Camera: NIDEK AFC-230 — 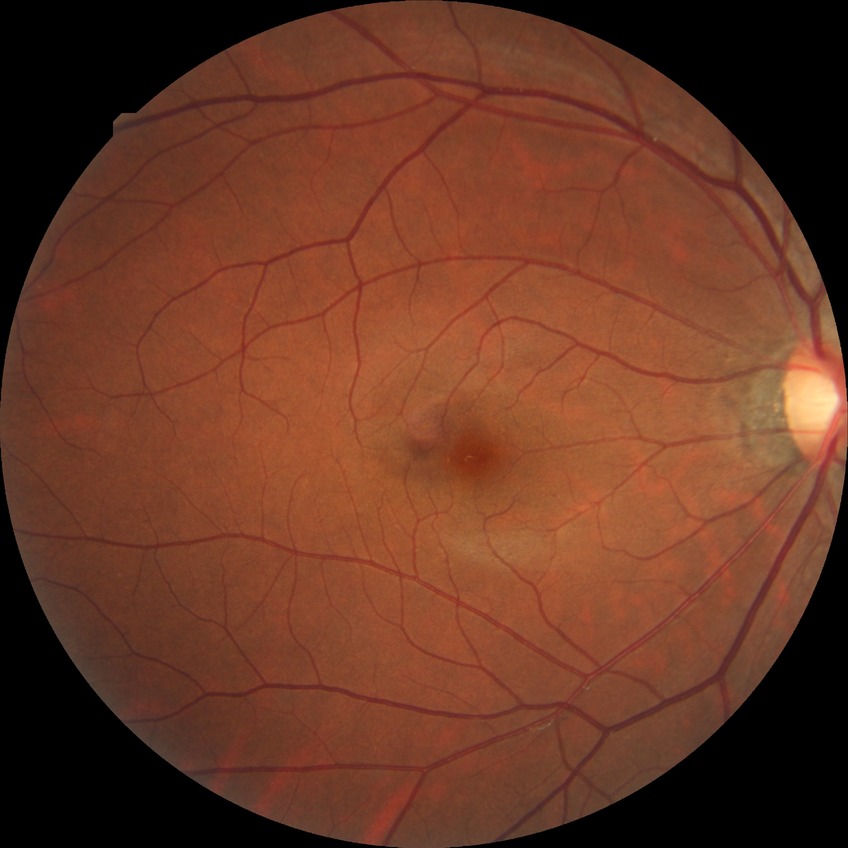

  davis_grade: NDR (no diabetic retinopathy)